Fundus photo. 45° field of view: 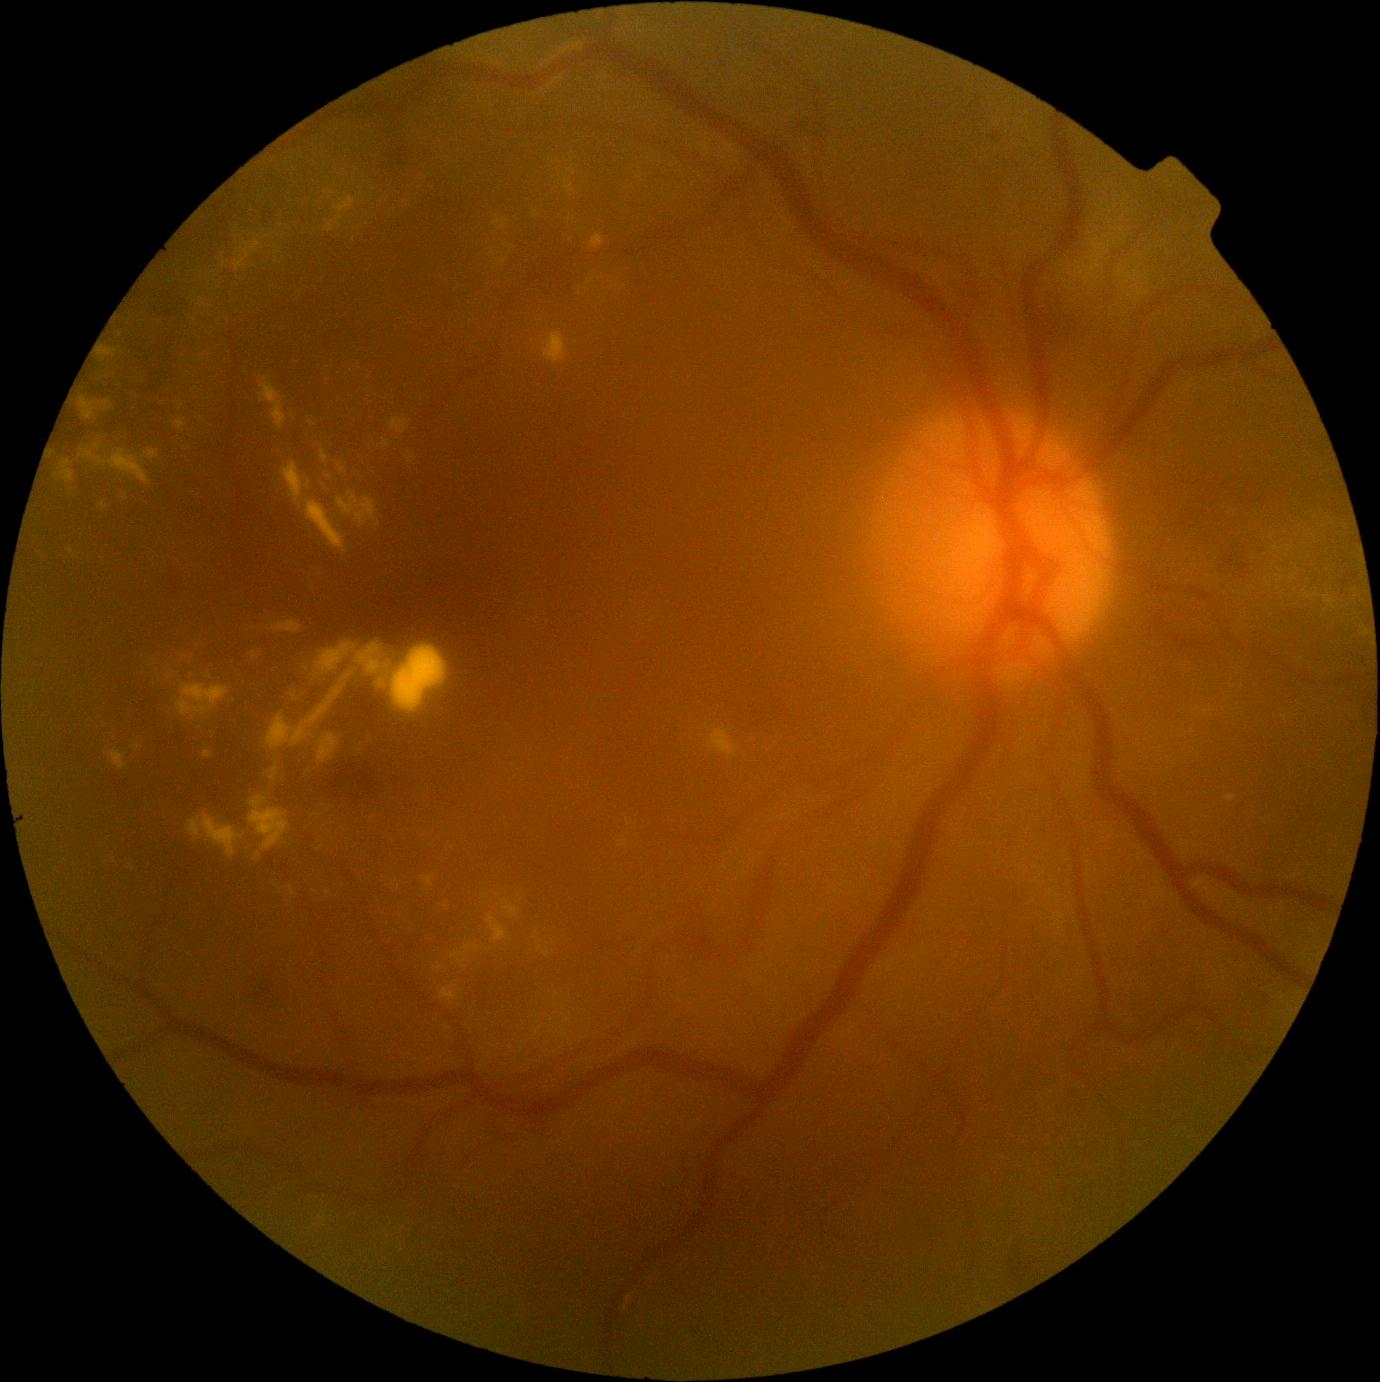

Diabetic retinopathy severity is grade 2 (moderate NPDR)
Selected lesions:
hard exudates (continued): left=288, top=885, right=296, bottom=896; left=55, top=460, right=75, bottom=484; left=281, top=462, right=311, bottom=508; left=1120, top=268, right=1128, bottom=275; left=79, top=447, right=152, bottom=487; left=202, top=748, right=215, bottom=760; left=382, top=441, right=390, bottom=449; left=542, top=332, right=568, bottom=364; left=327, top=217, right=342, bottom=232; left=503, top=901, right=519, bottom=920; left=176, top=419, right=187, bottom=430
Hard exudates (small, approximate centers) near Point(136, 747); Point(425, 836); Point(208, 675); Point(171, 676); Point(224, 265); Point(1276, 549); Point(624, 843)